Modified Davis classification, 848x848px — 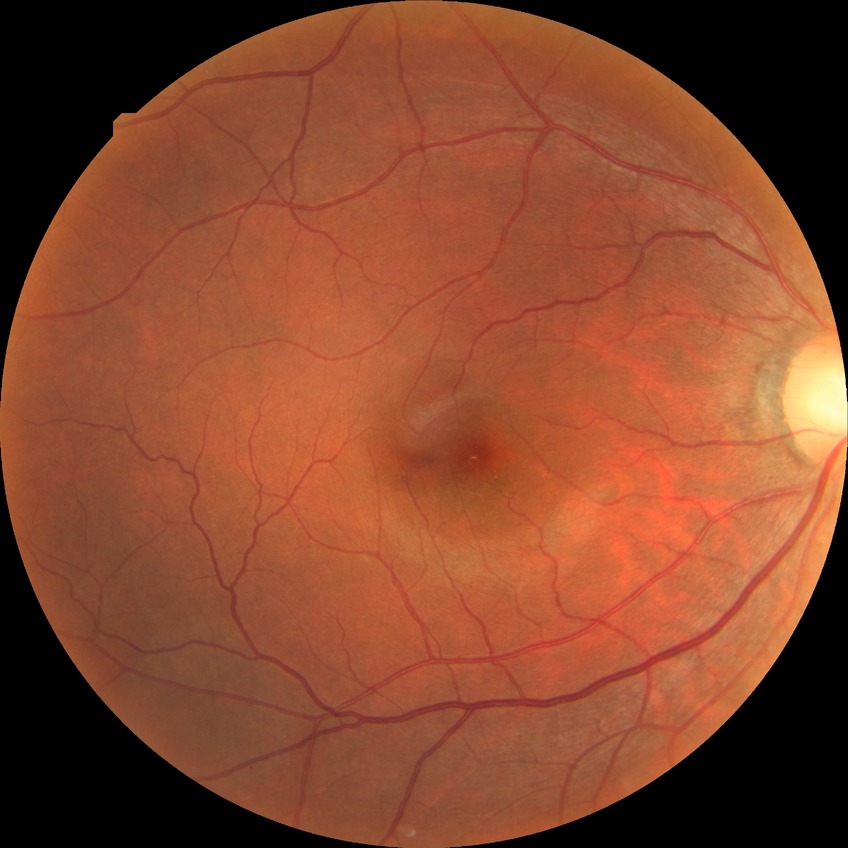
Davis grading is no diabetic retinopathy.